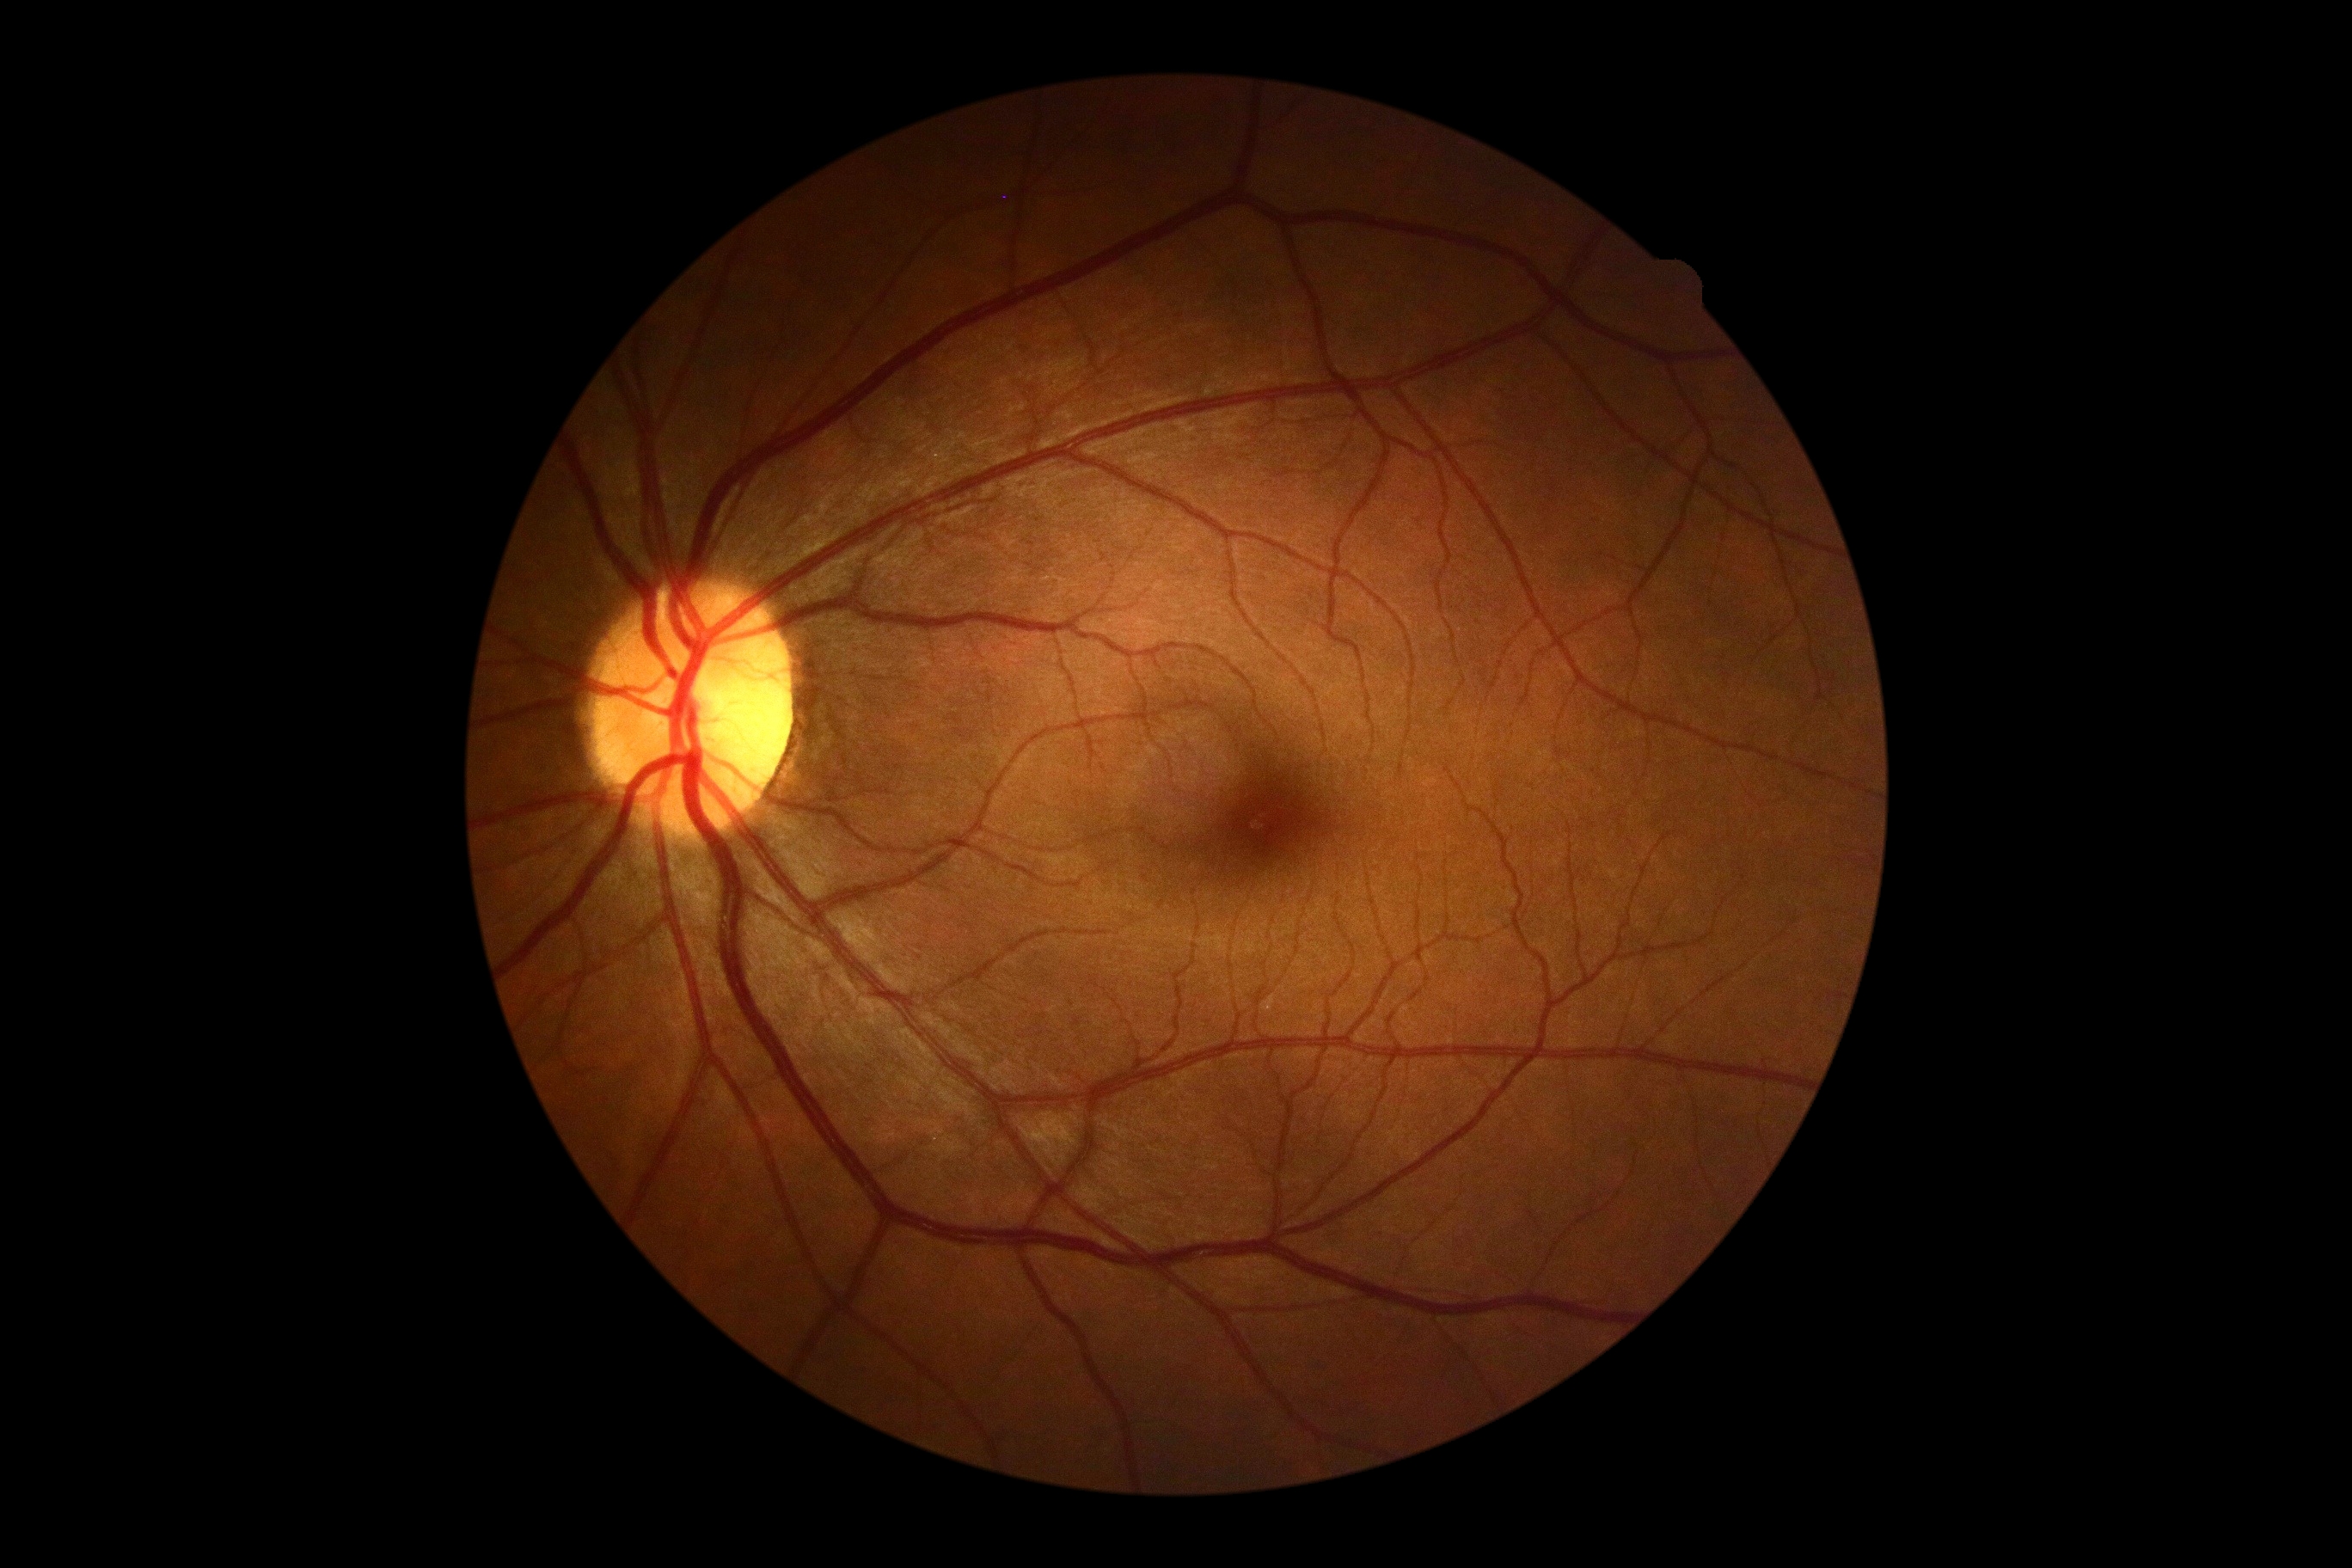

  dr_grade: grade 0 (no apparent retinopathy)